Nonmydriatic fundus photograph, 45° field of view — 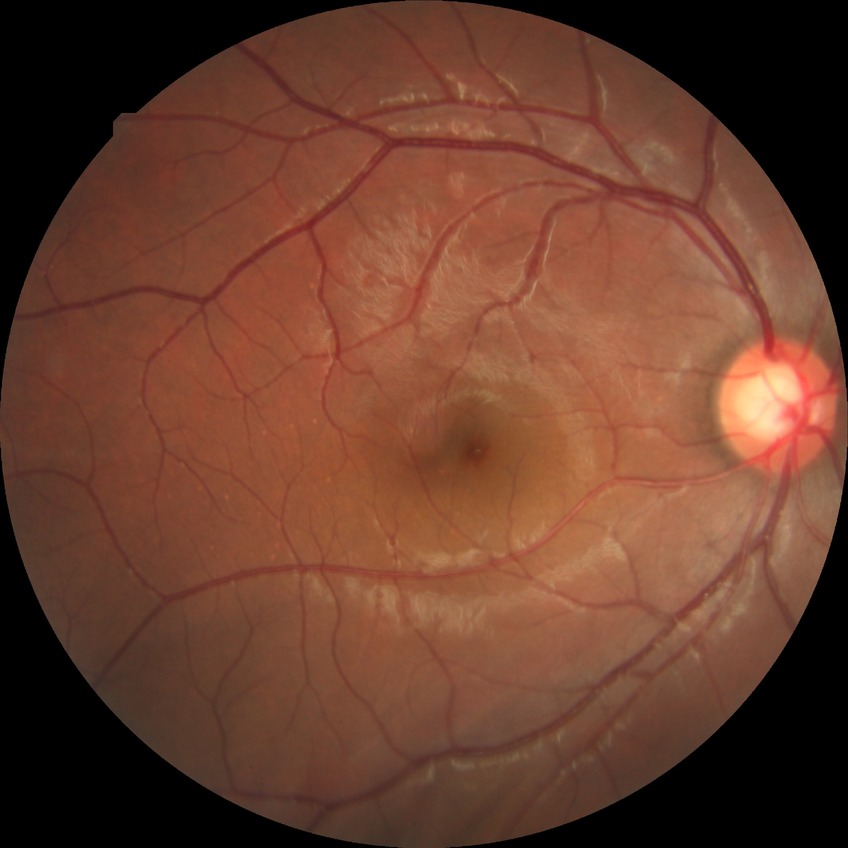

DR@NDR, DR impression@no apparent DR.